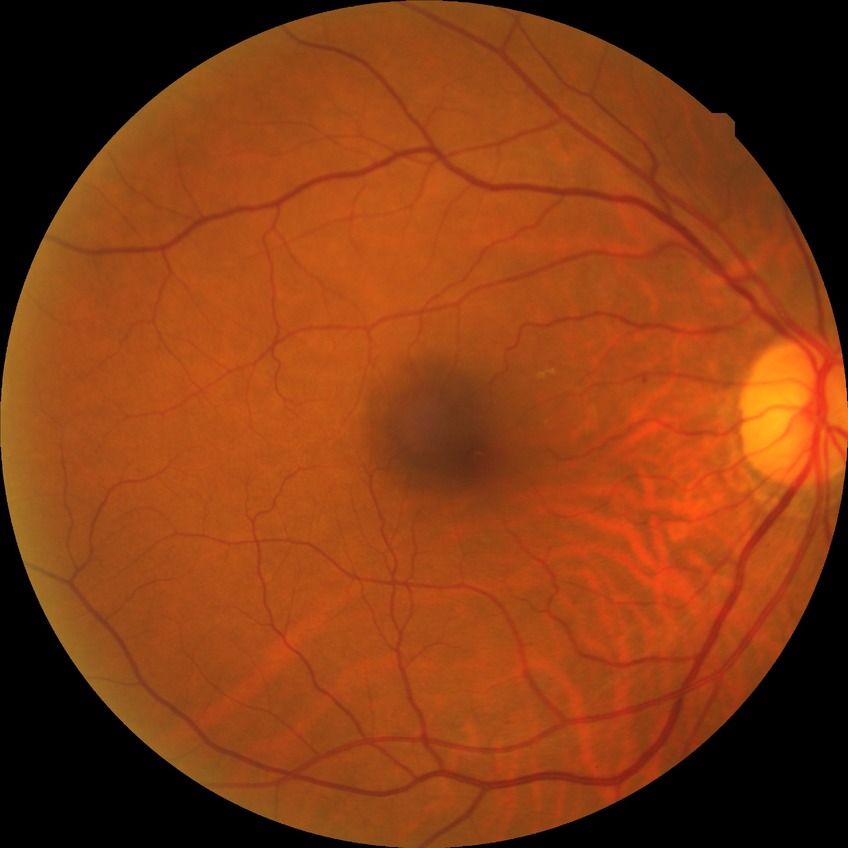

Diabetic retinopathy (DR) is no diabetic retinopathy (NDR).